45° field of view · fundus photo — 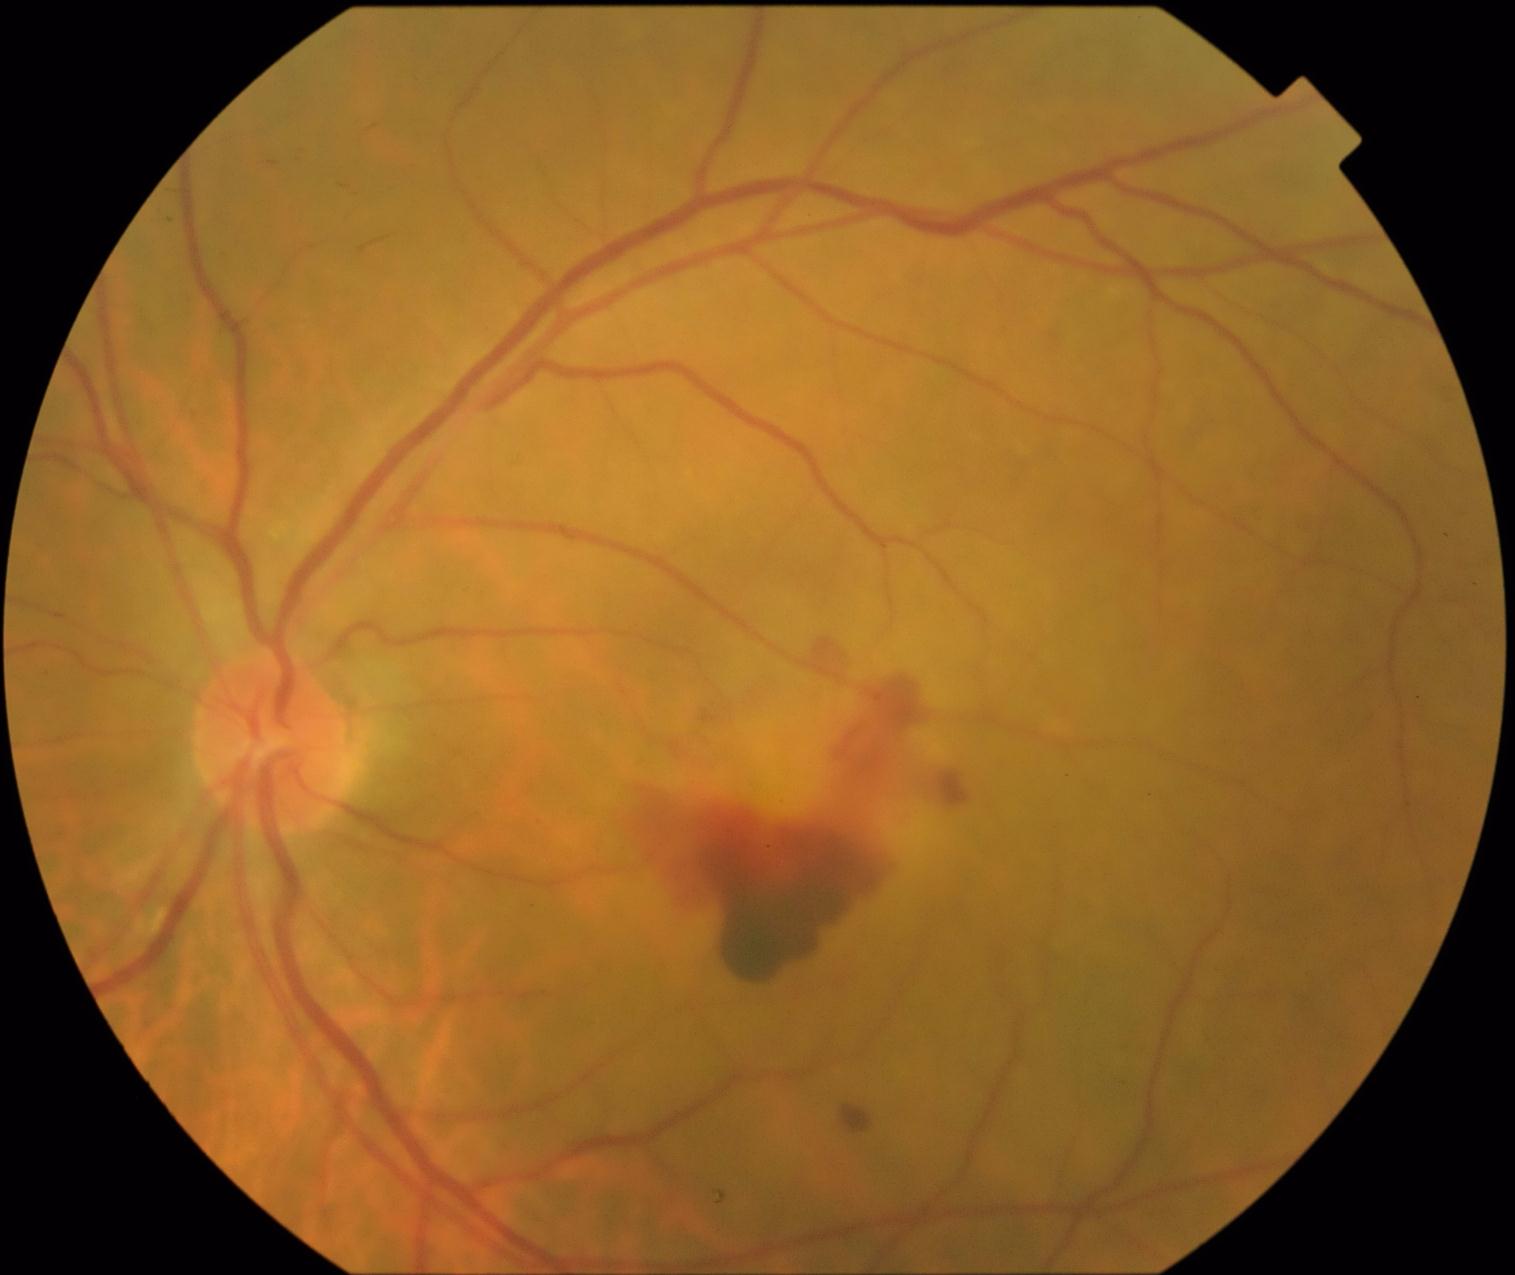
Diabetic retinopathy (DR) is 4/4
soft exudates (SEs): not present
hard exudates (EXs): not present
microaneurysms (MAs): not present
hemorrhages (HEs): (843, 1107, 872, 1135) | (805, 639, 843, 678) | (608, 673, 979, 985) | (1044, 334, 1066, 359)